640 by 480 pixels; wide-field fundus photograph of an infant — 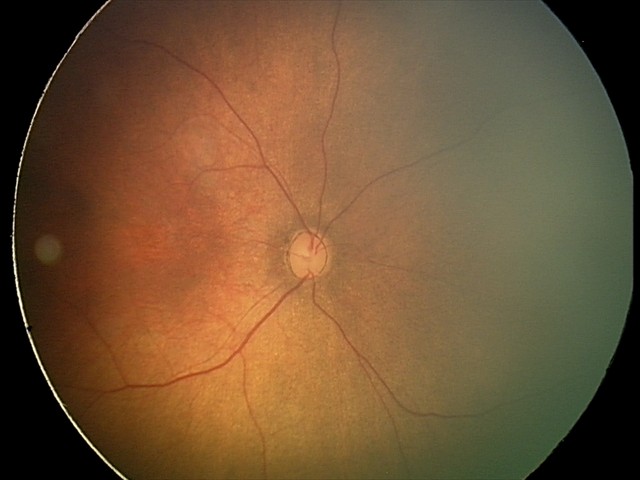
Screening examination with no abnormal retinal findings.